Image size 1725x1721, CFP
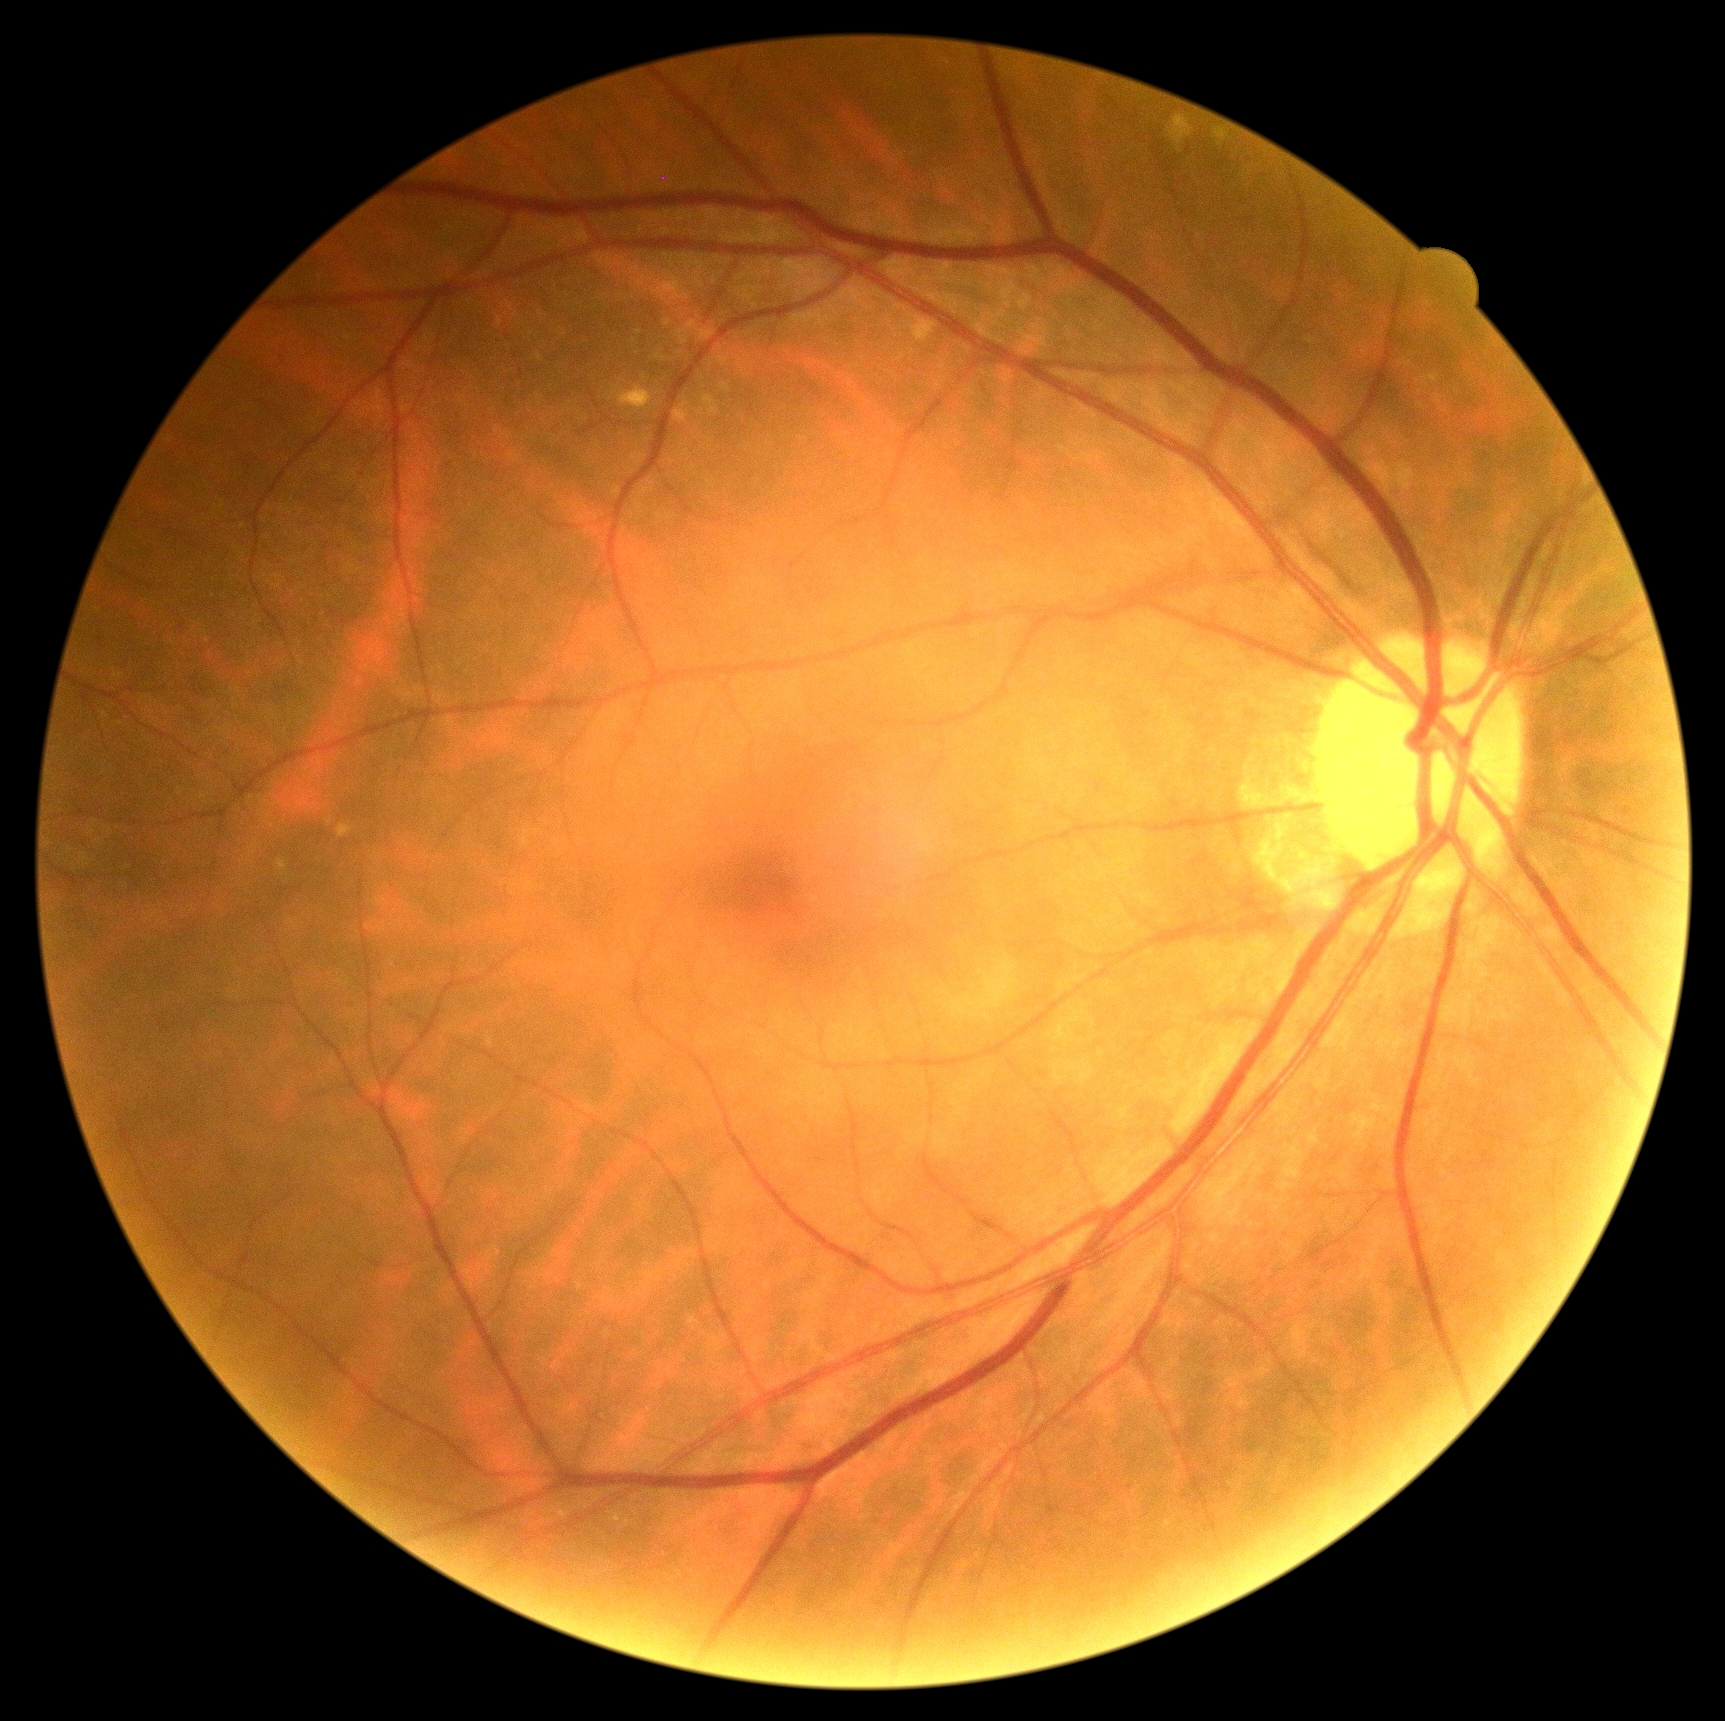

DR severity = no apparent retinopathy (grade 0).